45° FOV. NIDEK AFC-230. Nonmydriatic fundus photograph. Modified Davis classification:
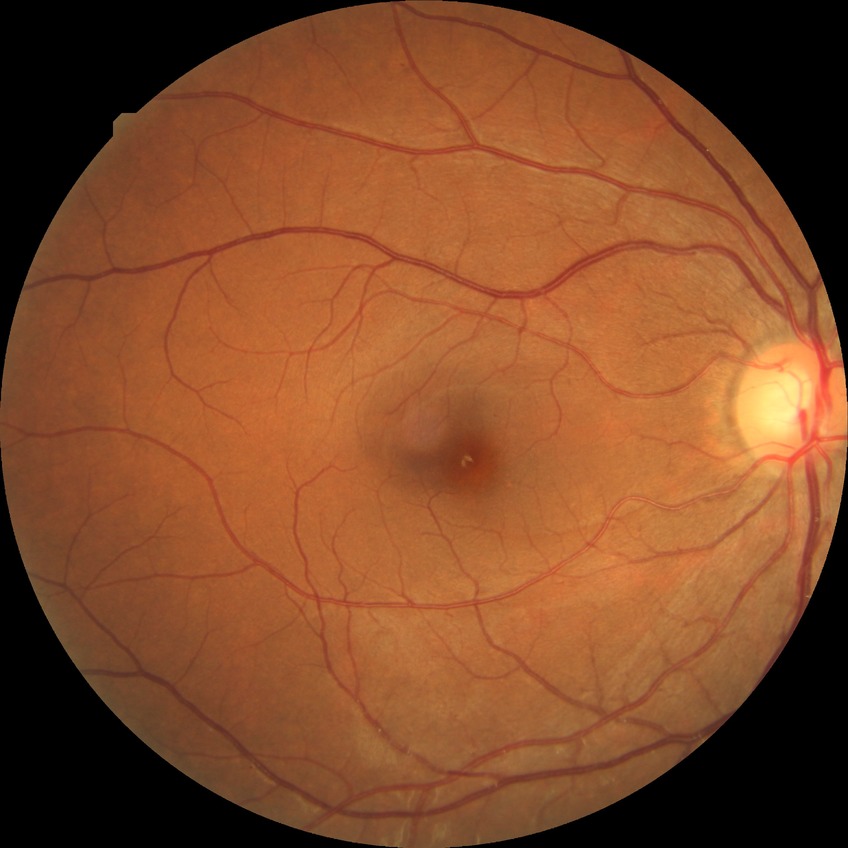
Diabetic retinopathy severity is simple diabetic retinopathy.